Color fundus image.
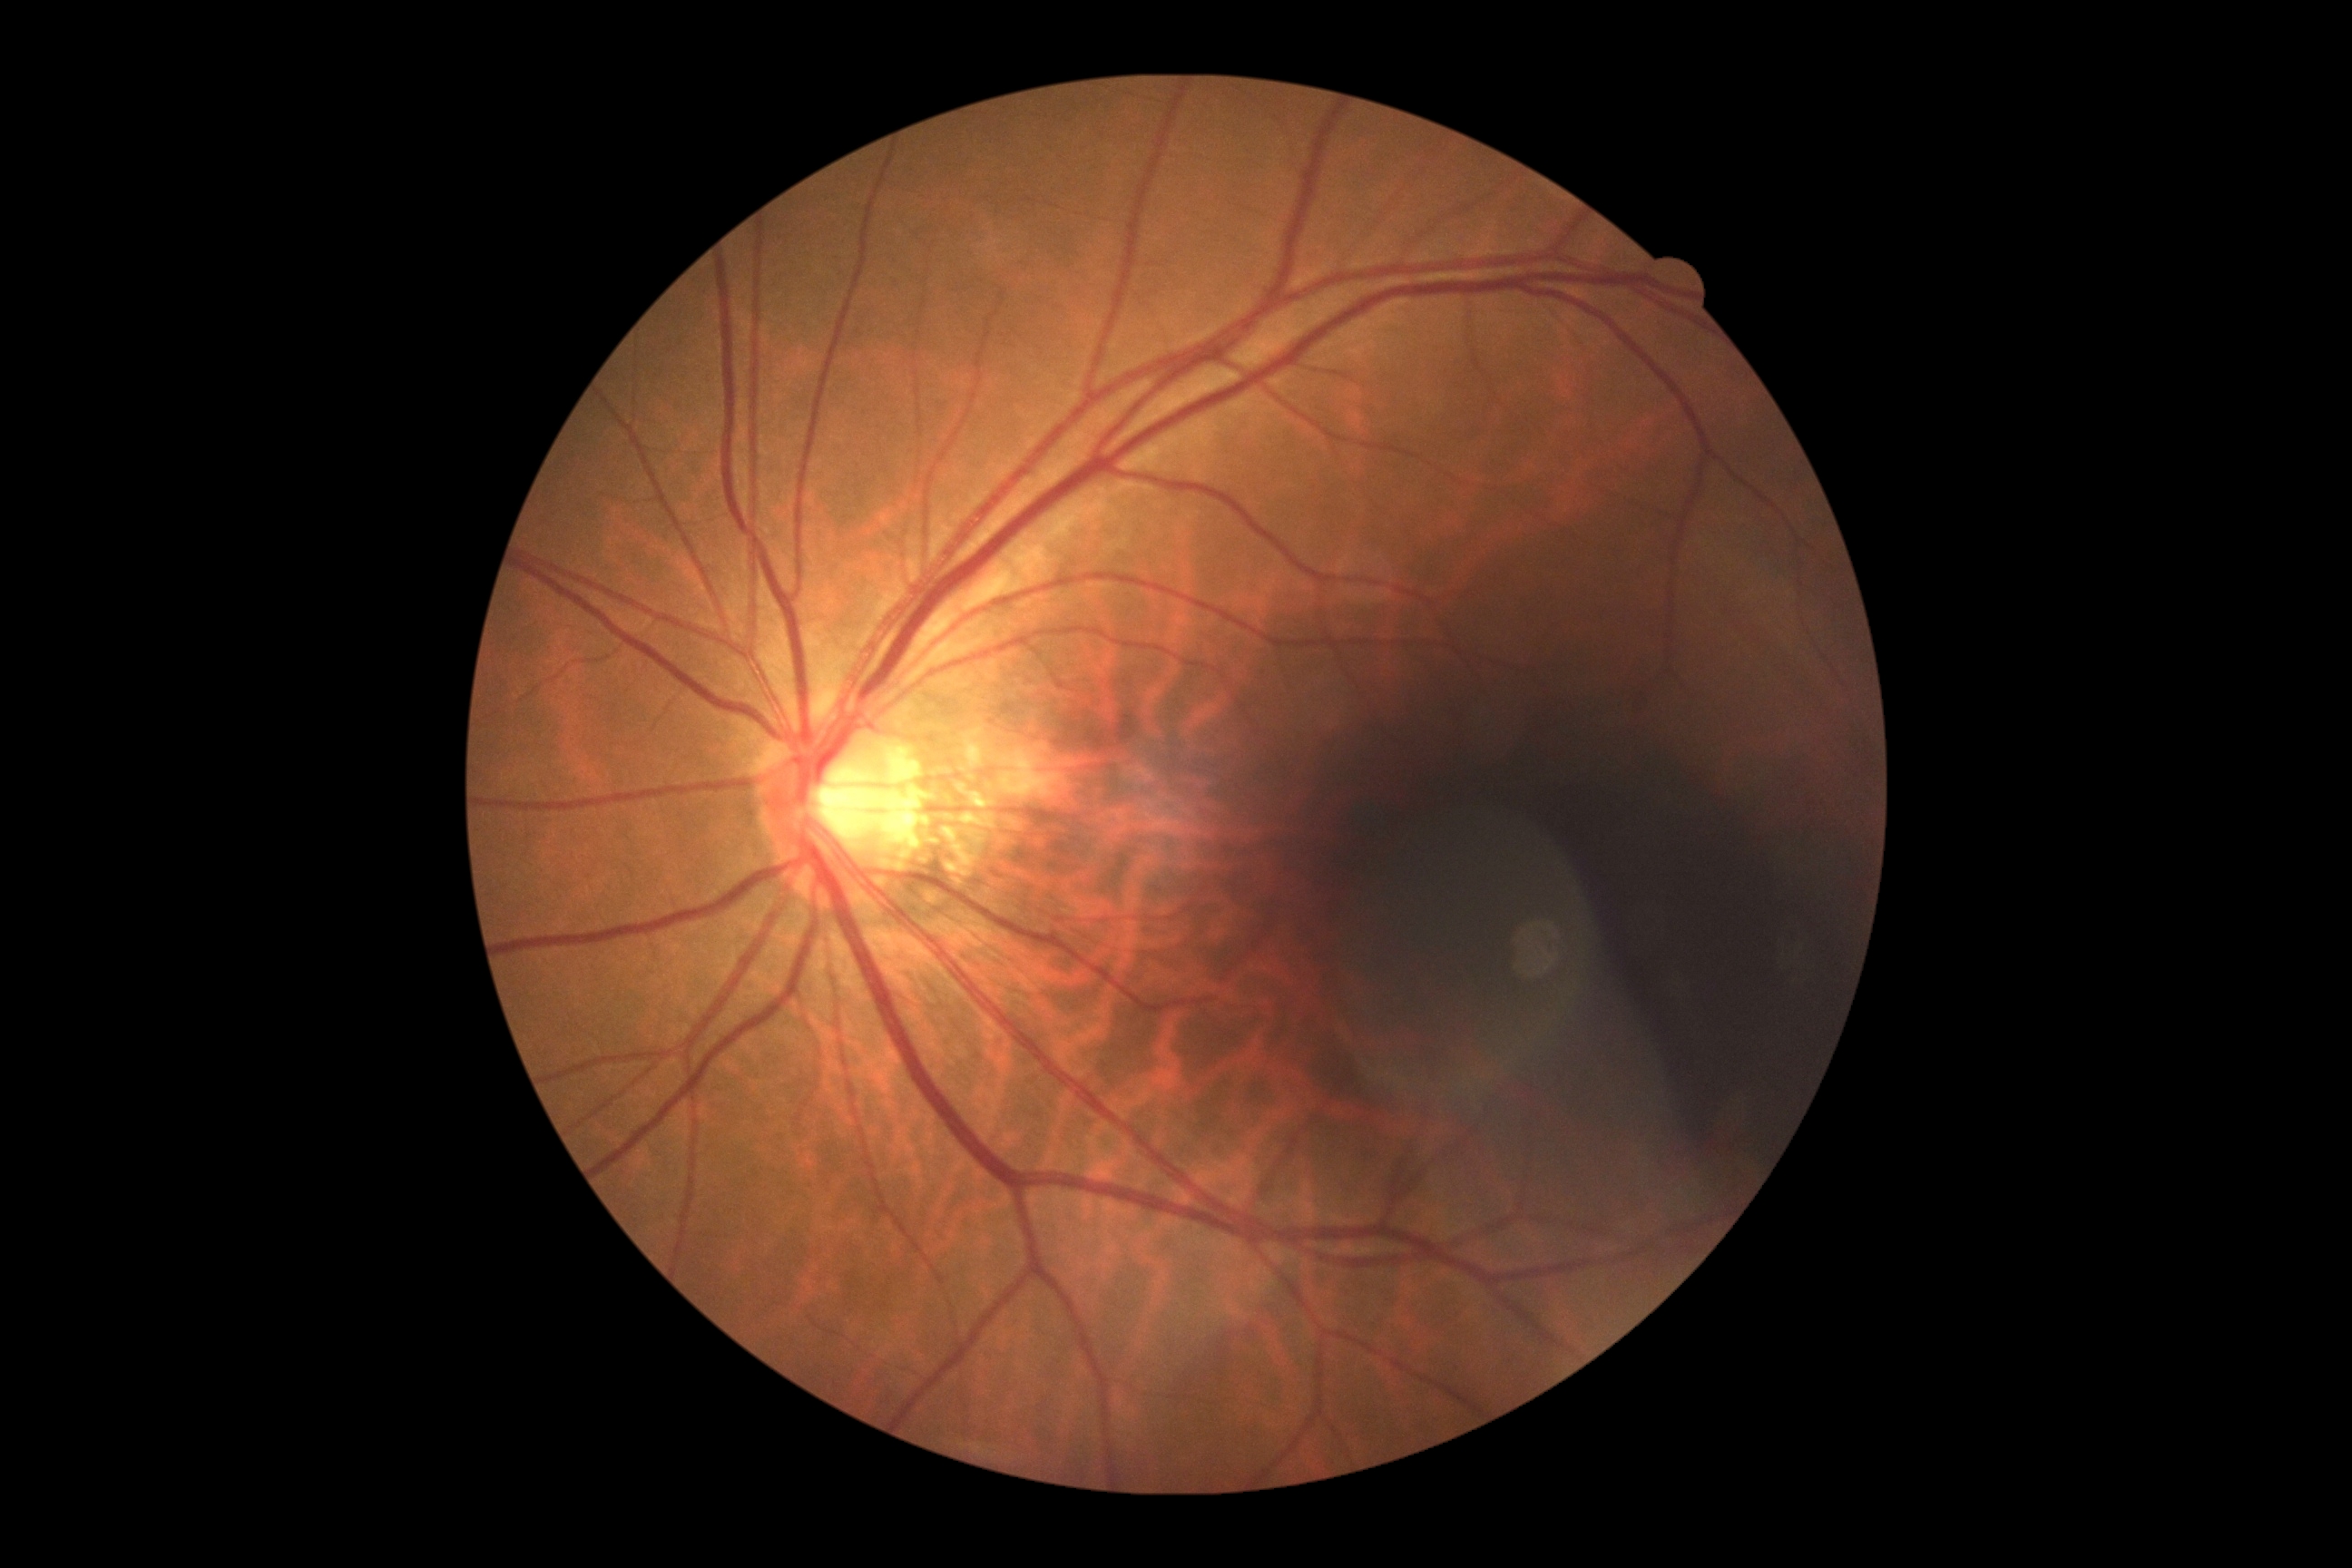
Retinopathy grade is 0 (no apparent retinopathy).